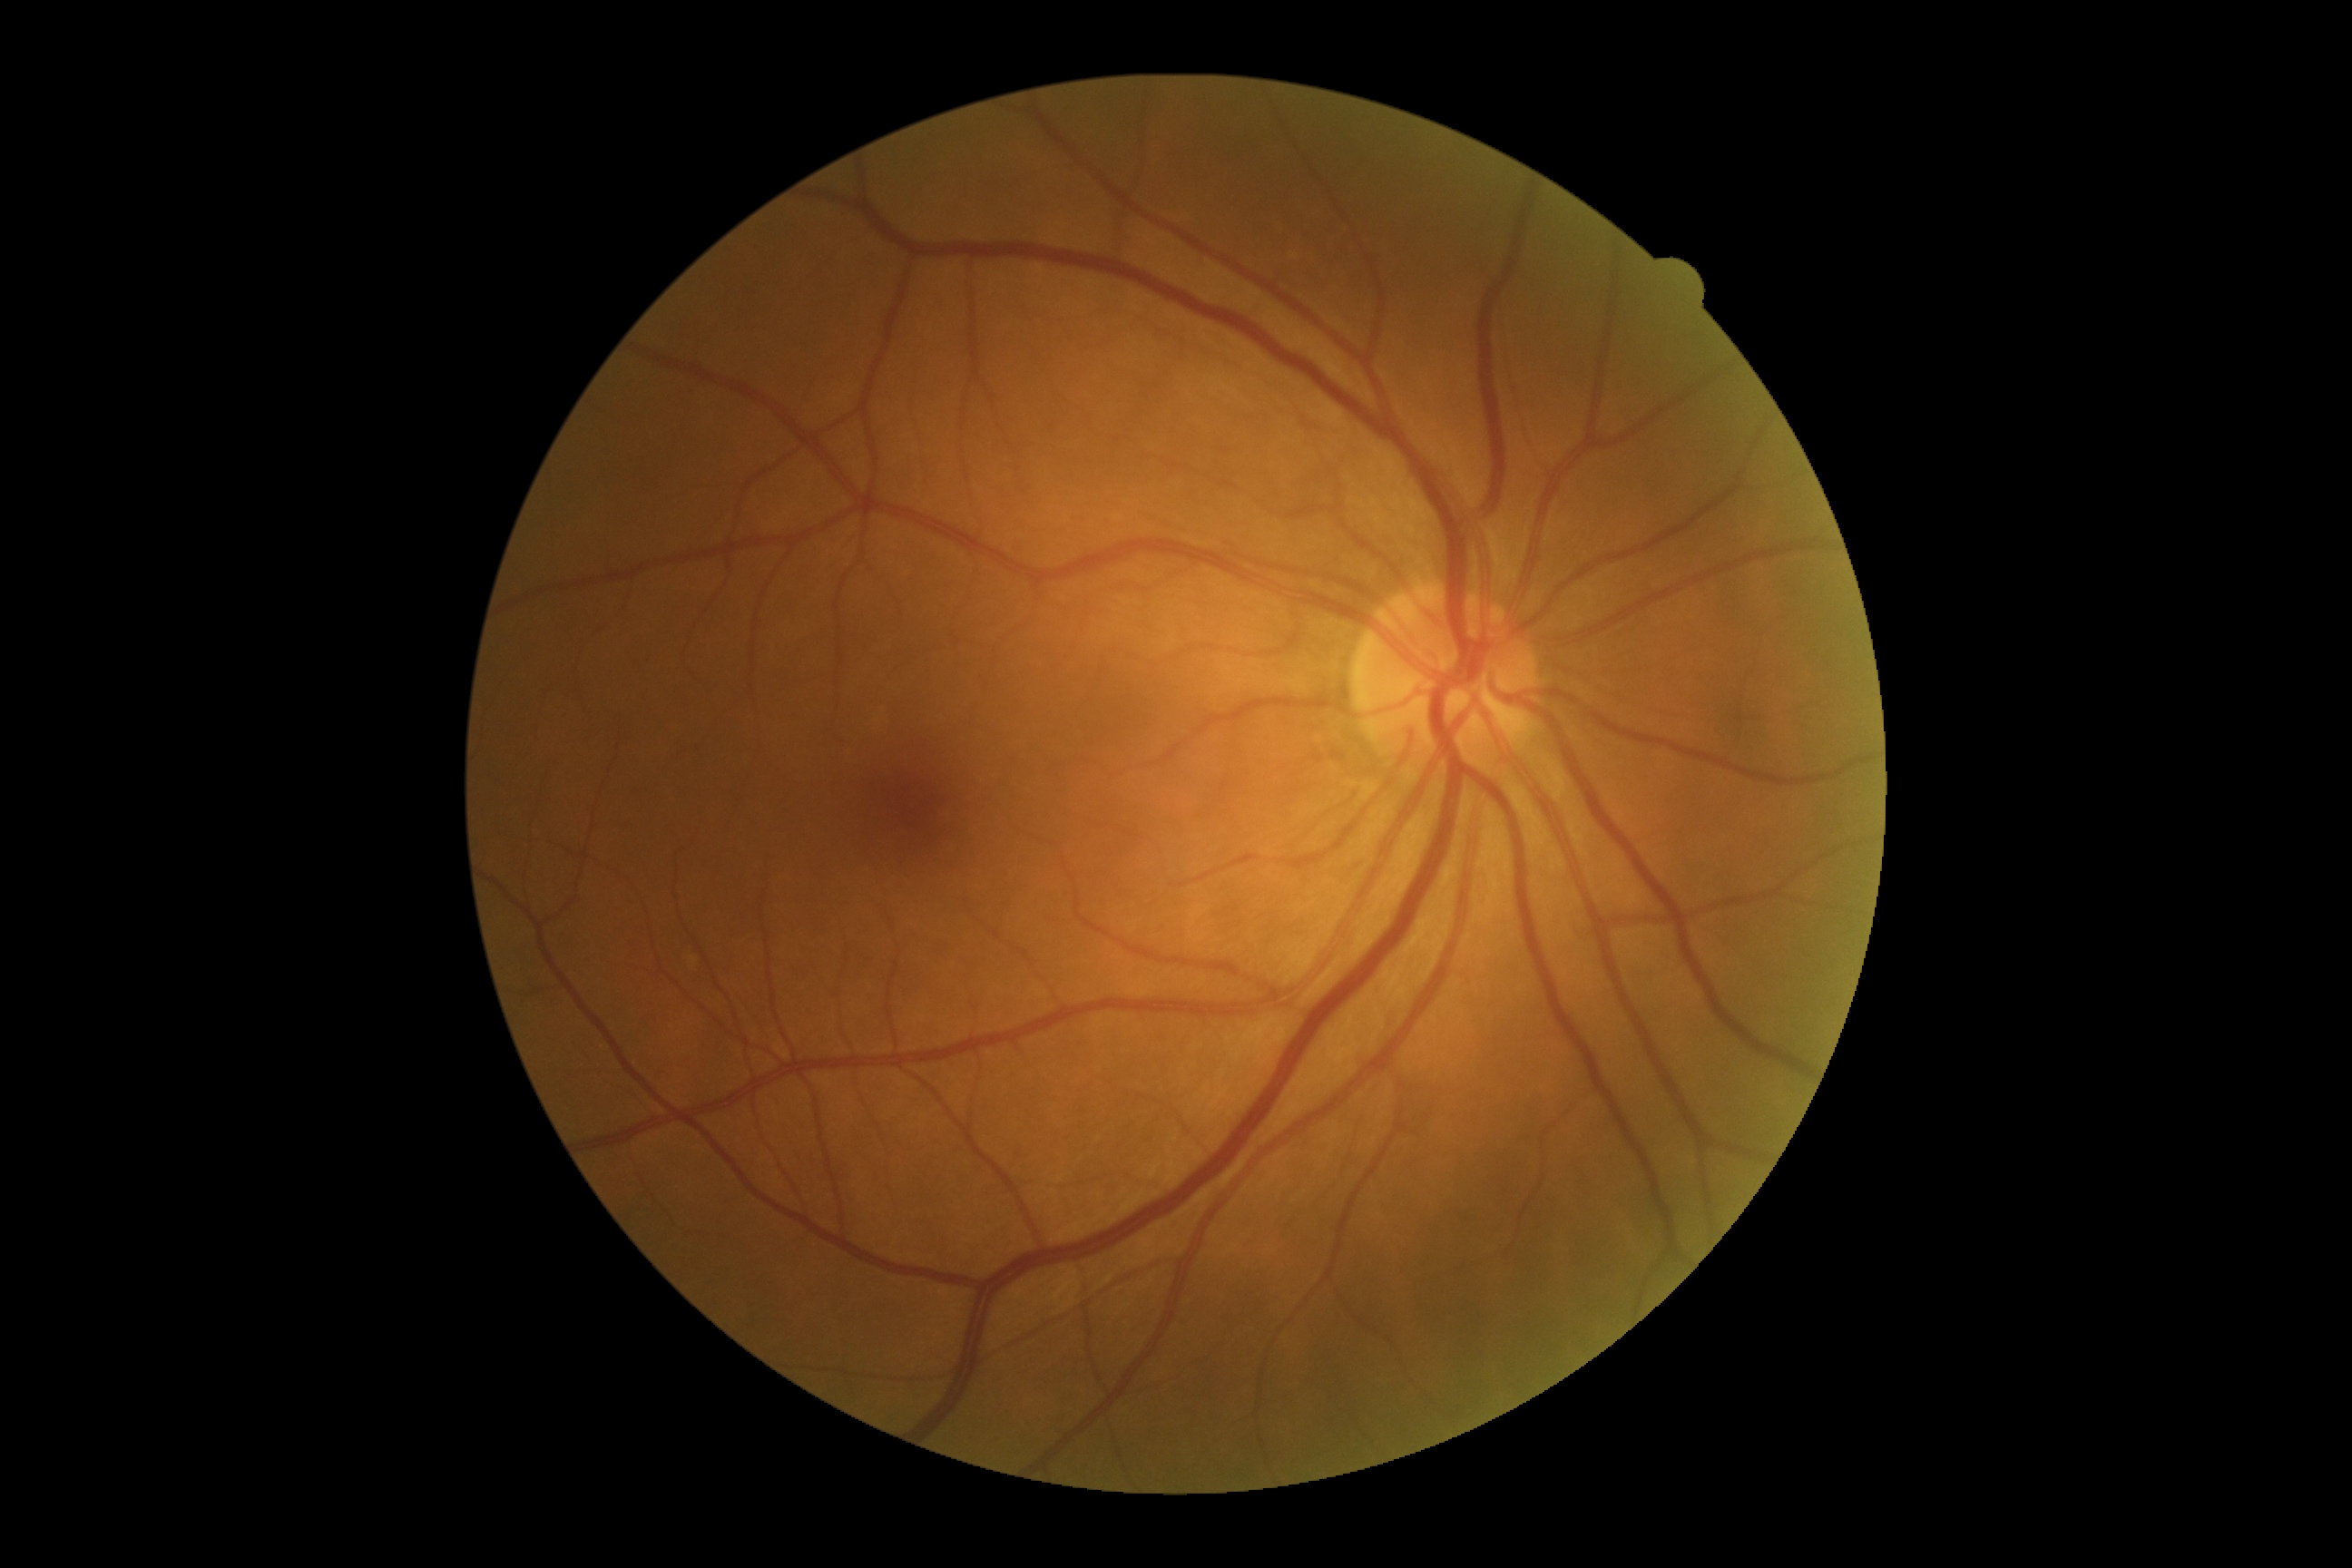

DR severity is grade 0 (no apparent retinopathy).